130° field of view (Clarity RetCam 3); pediatric wide-field fundus photograph — 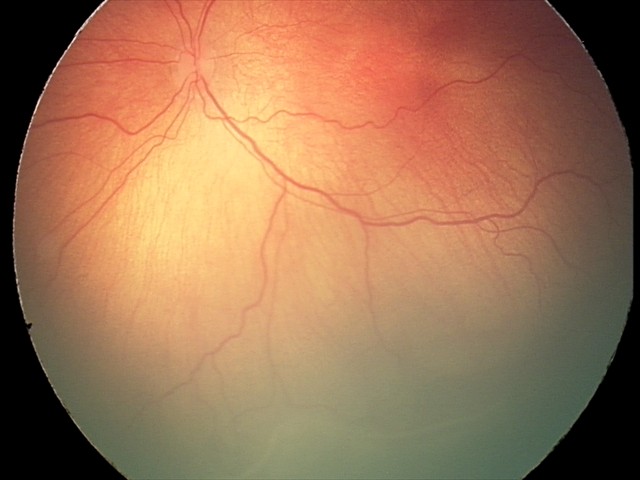
Impression = retinopathy of prematurity stage 2.